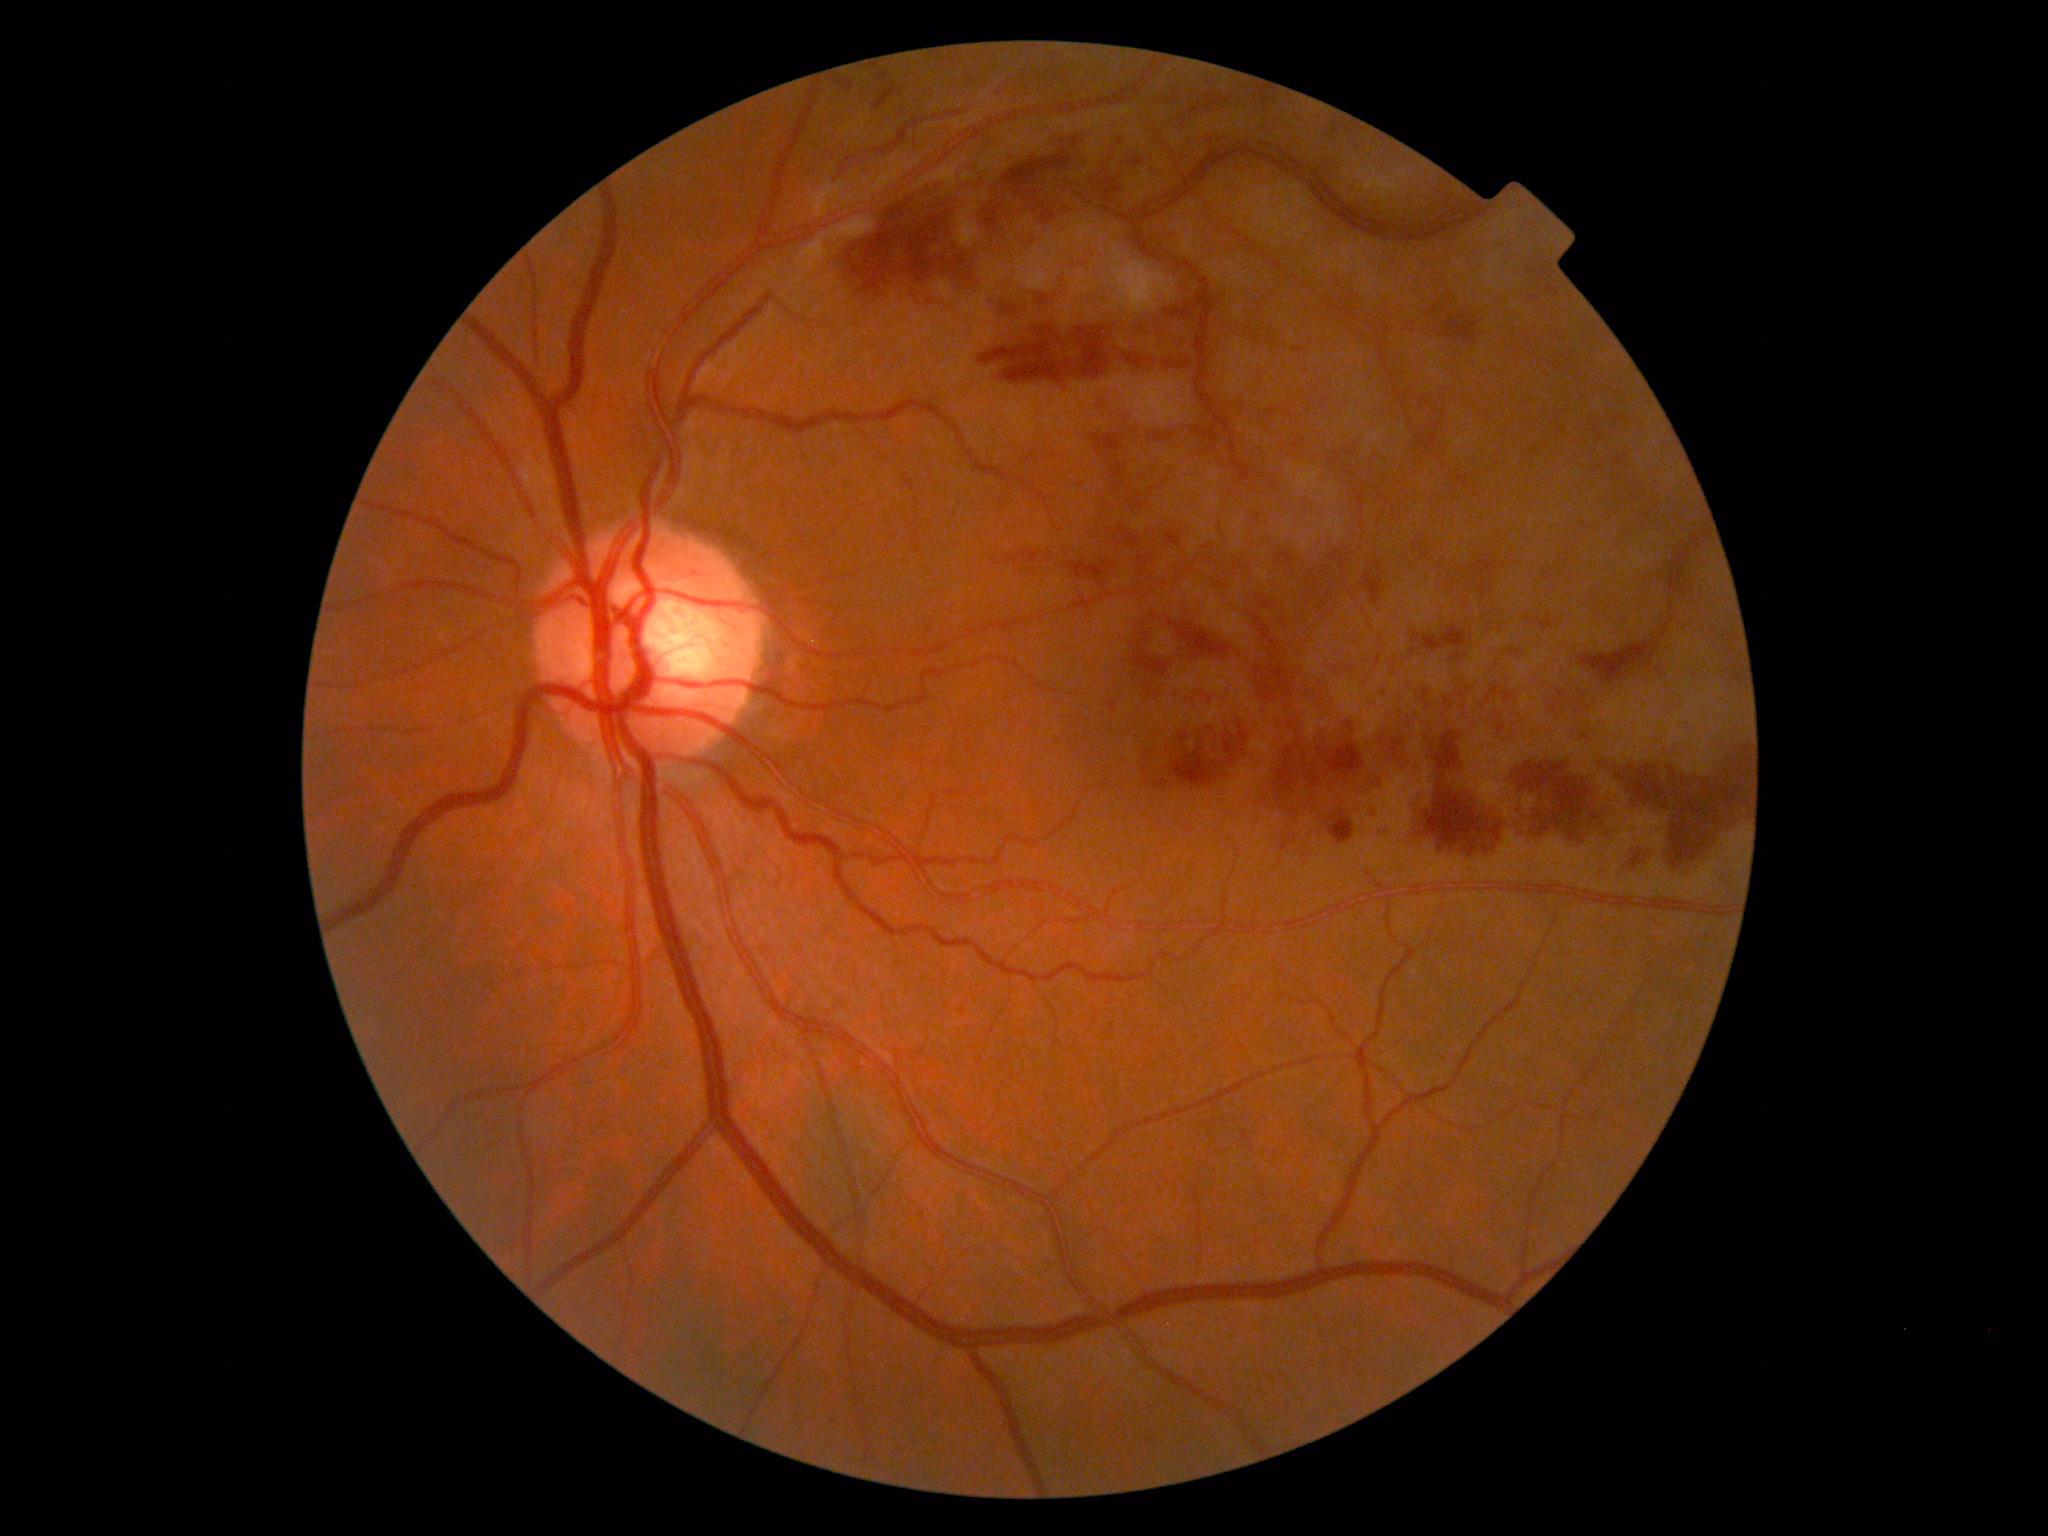
Diabetic retinopathy severity is 2/4 — more than just microaneurysms but less than severe NPDR.